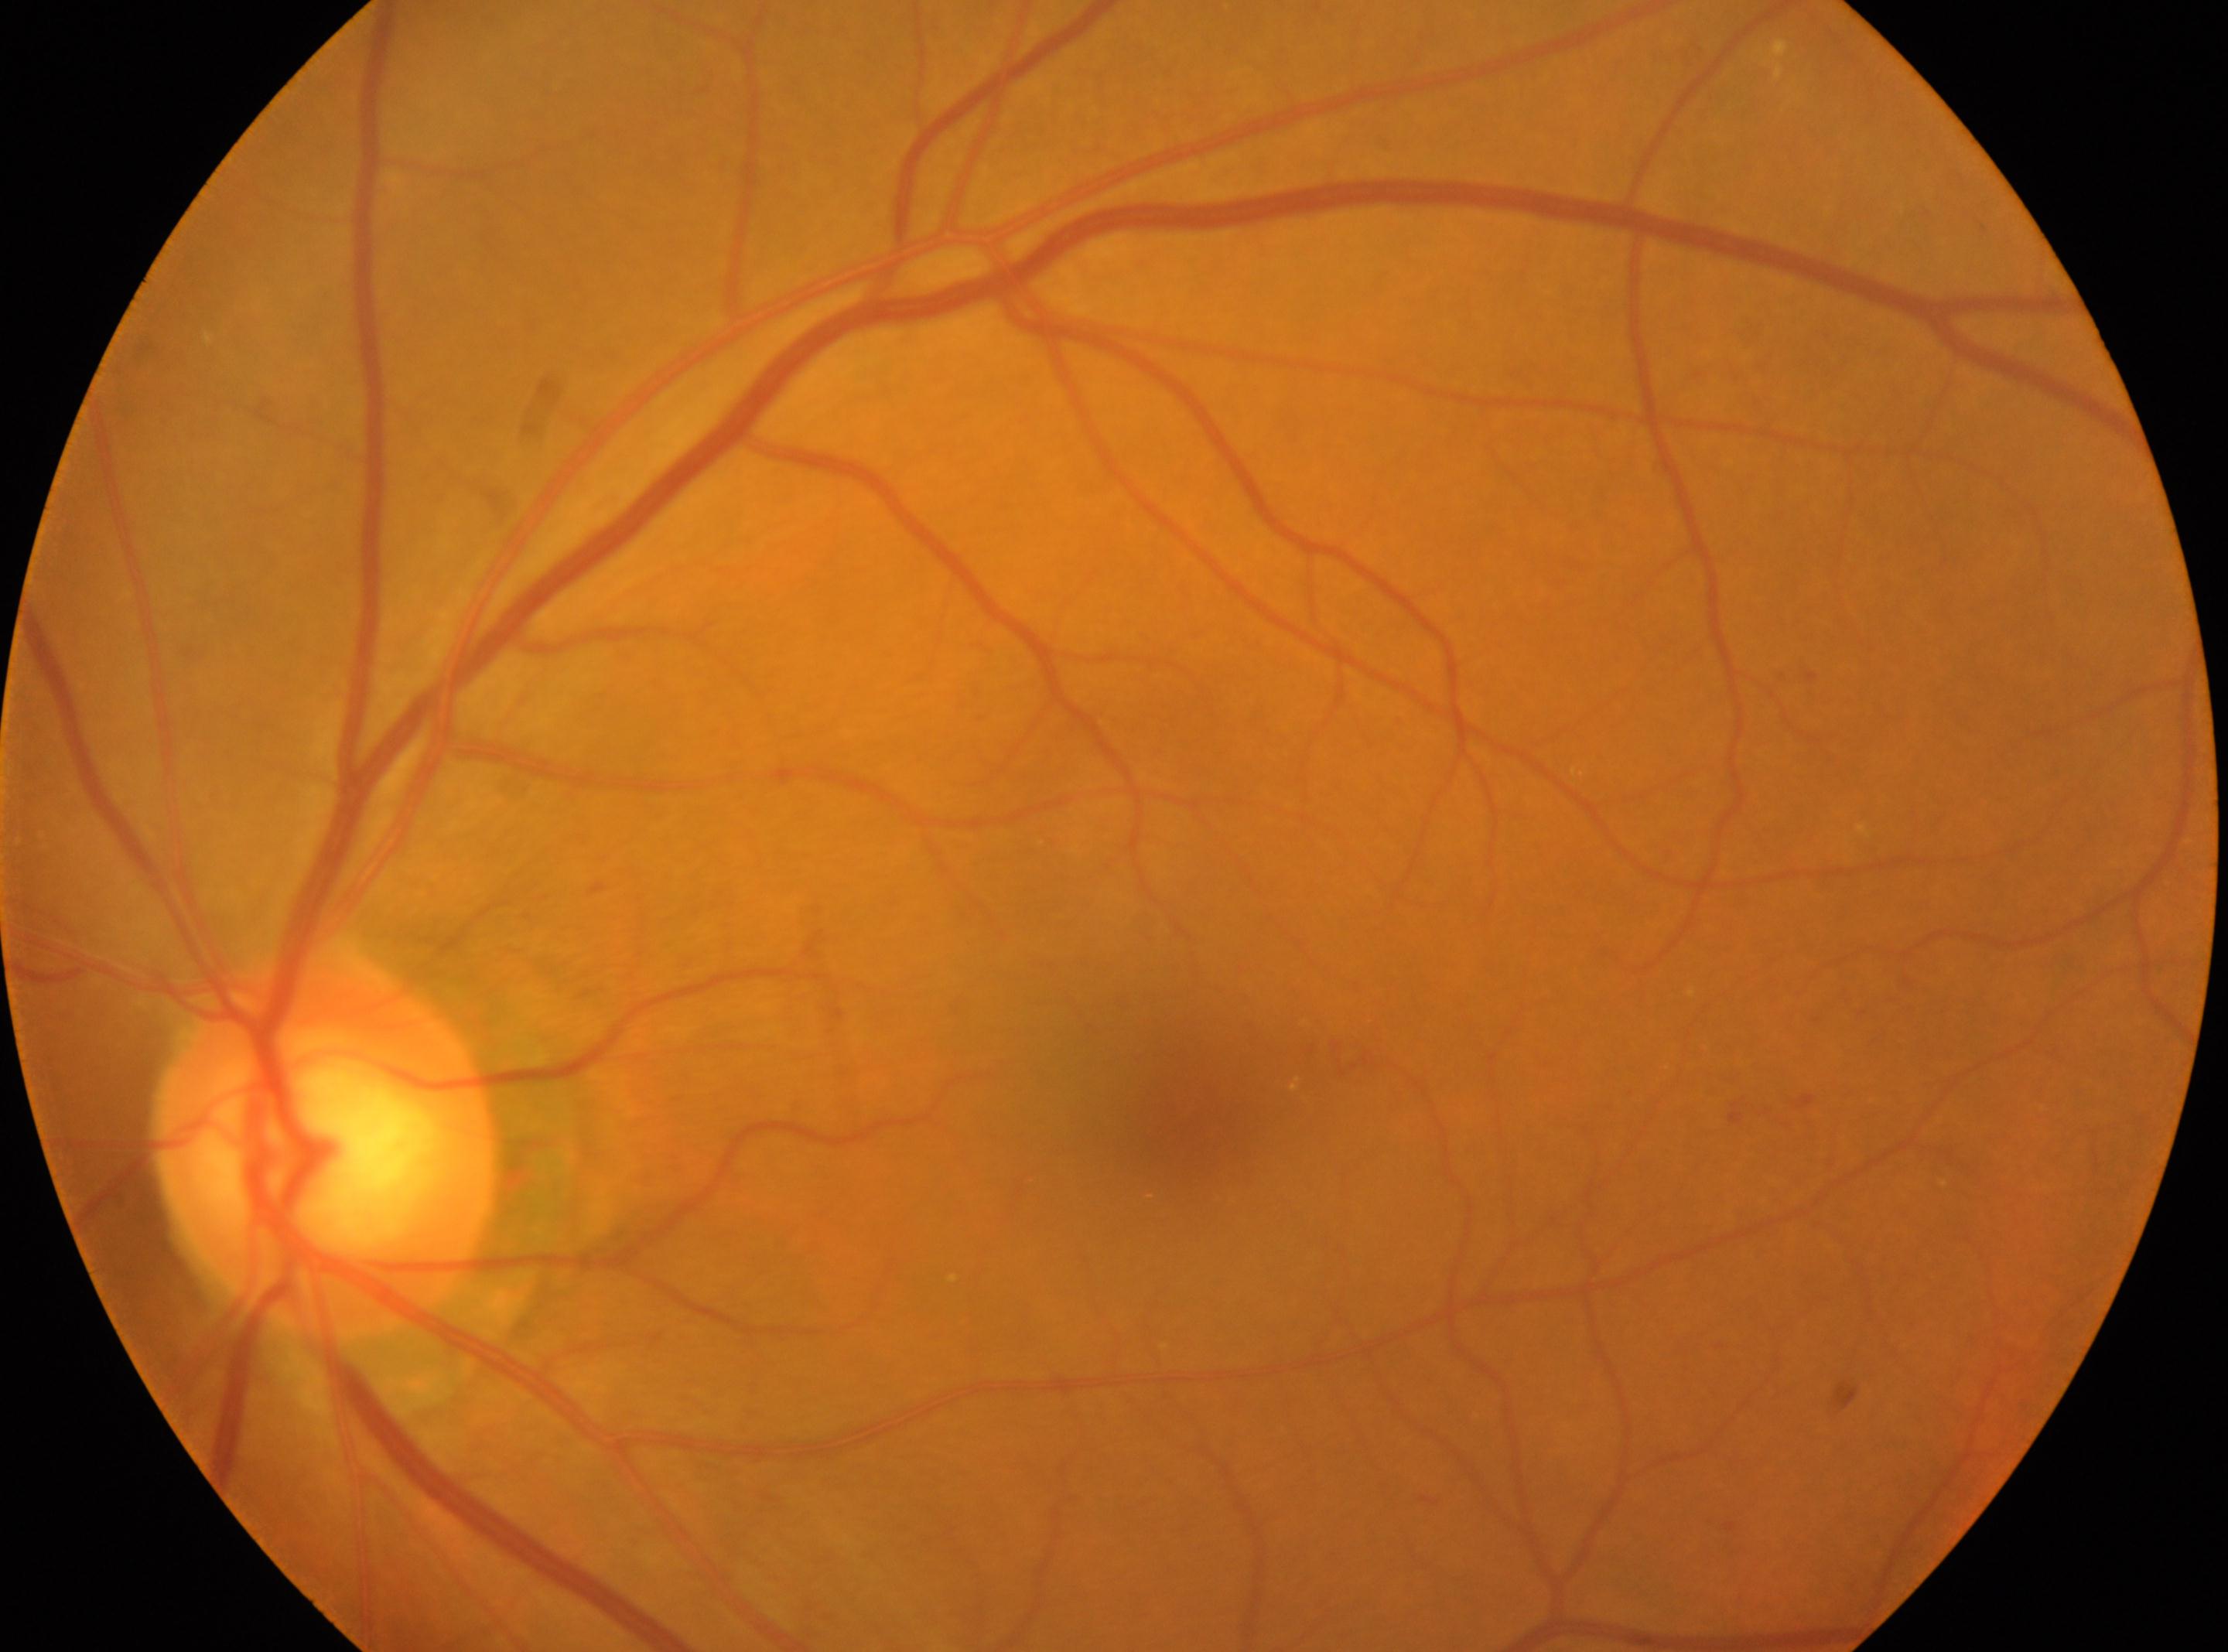 Retinopathy: grade 2.
Eye: the left eye.
Fovea: (x=1196, y=1114).
ONH: (x=323, y=1149).